Phoenix ICON wide-field infant fundus image: 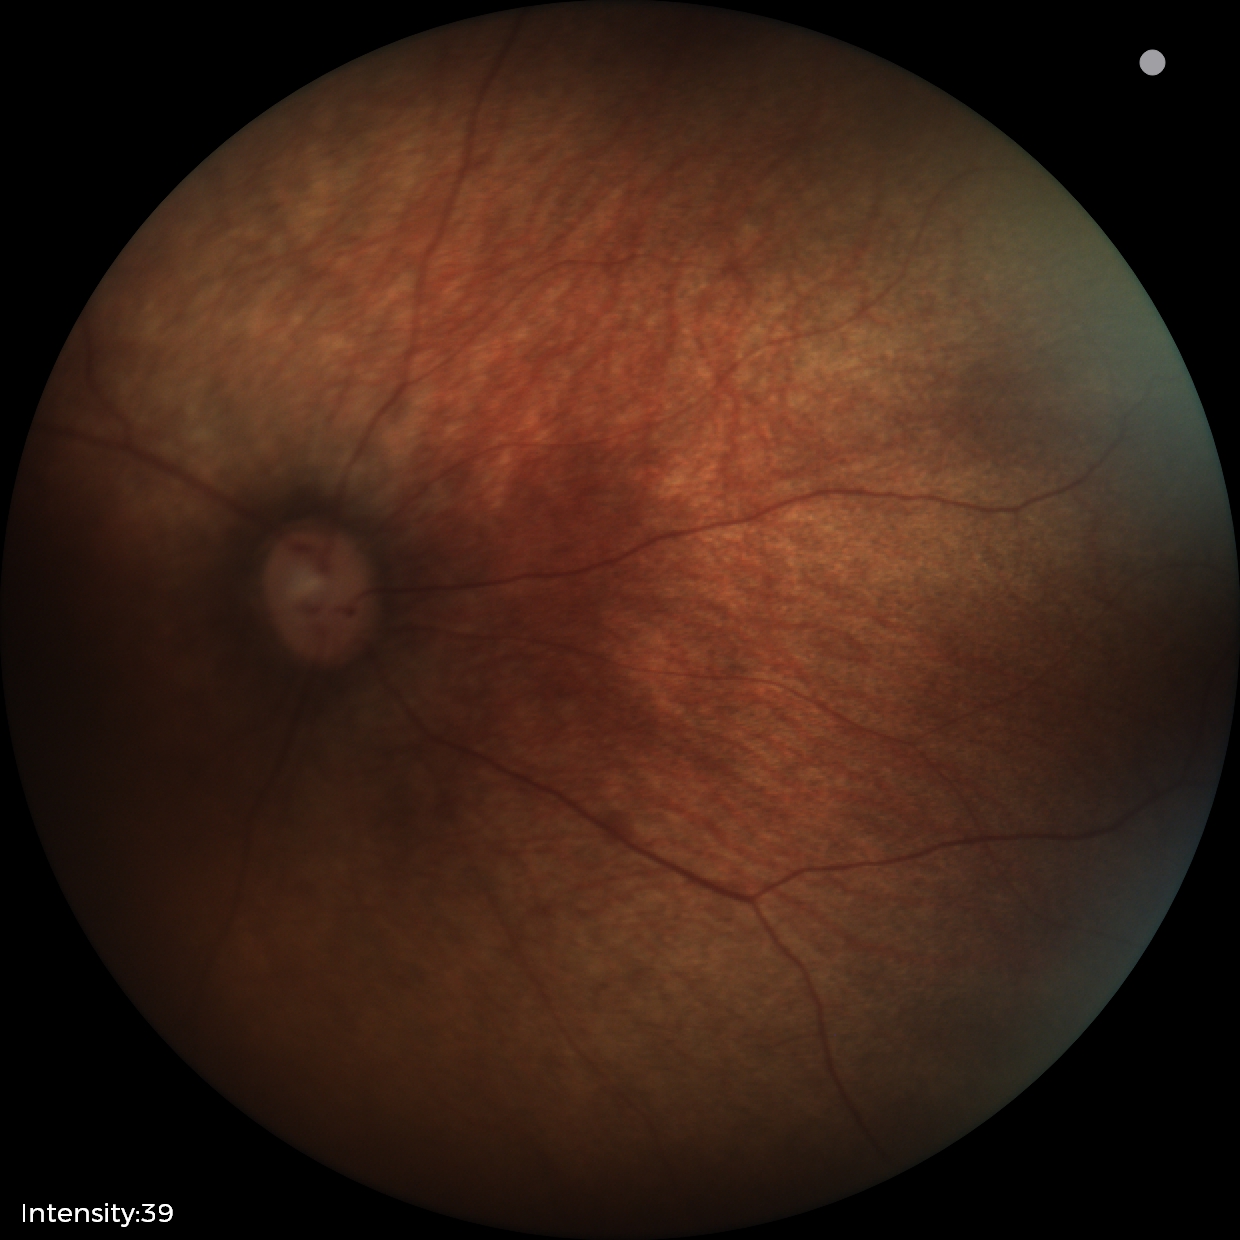
Q: What was the screening finding?
A: physiological appearance with no retinal pathology